848x848px — 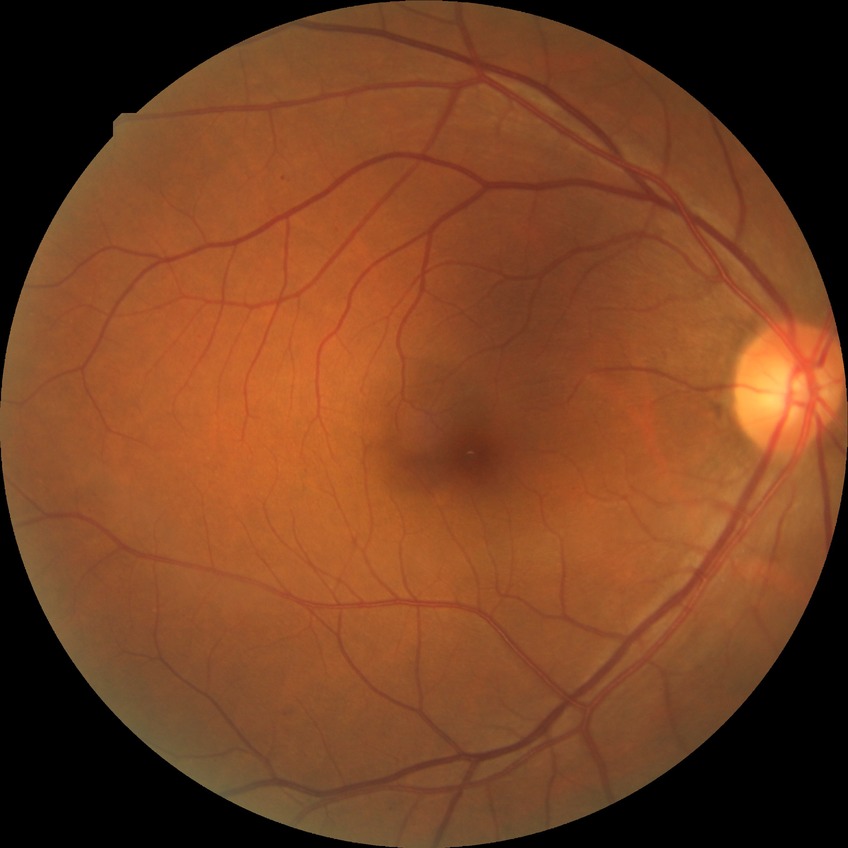 diabetic retinopathy (DR) = simple diabetic retinopathy (SDR).